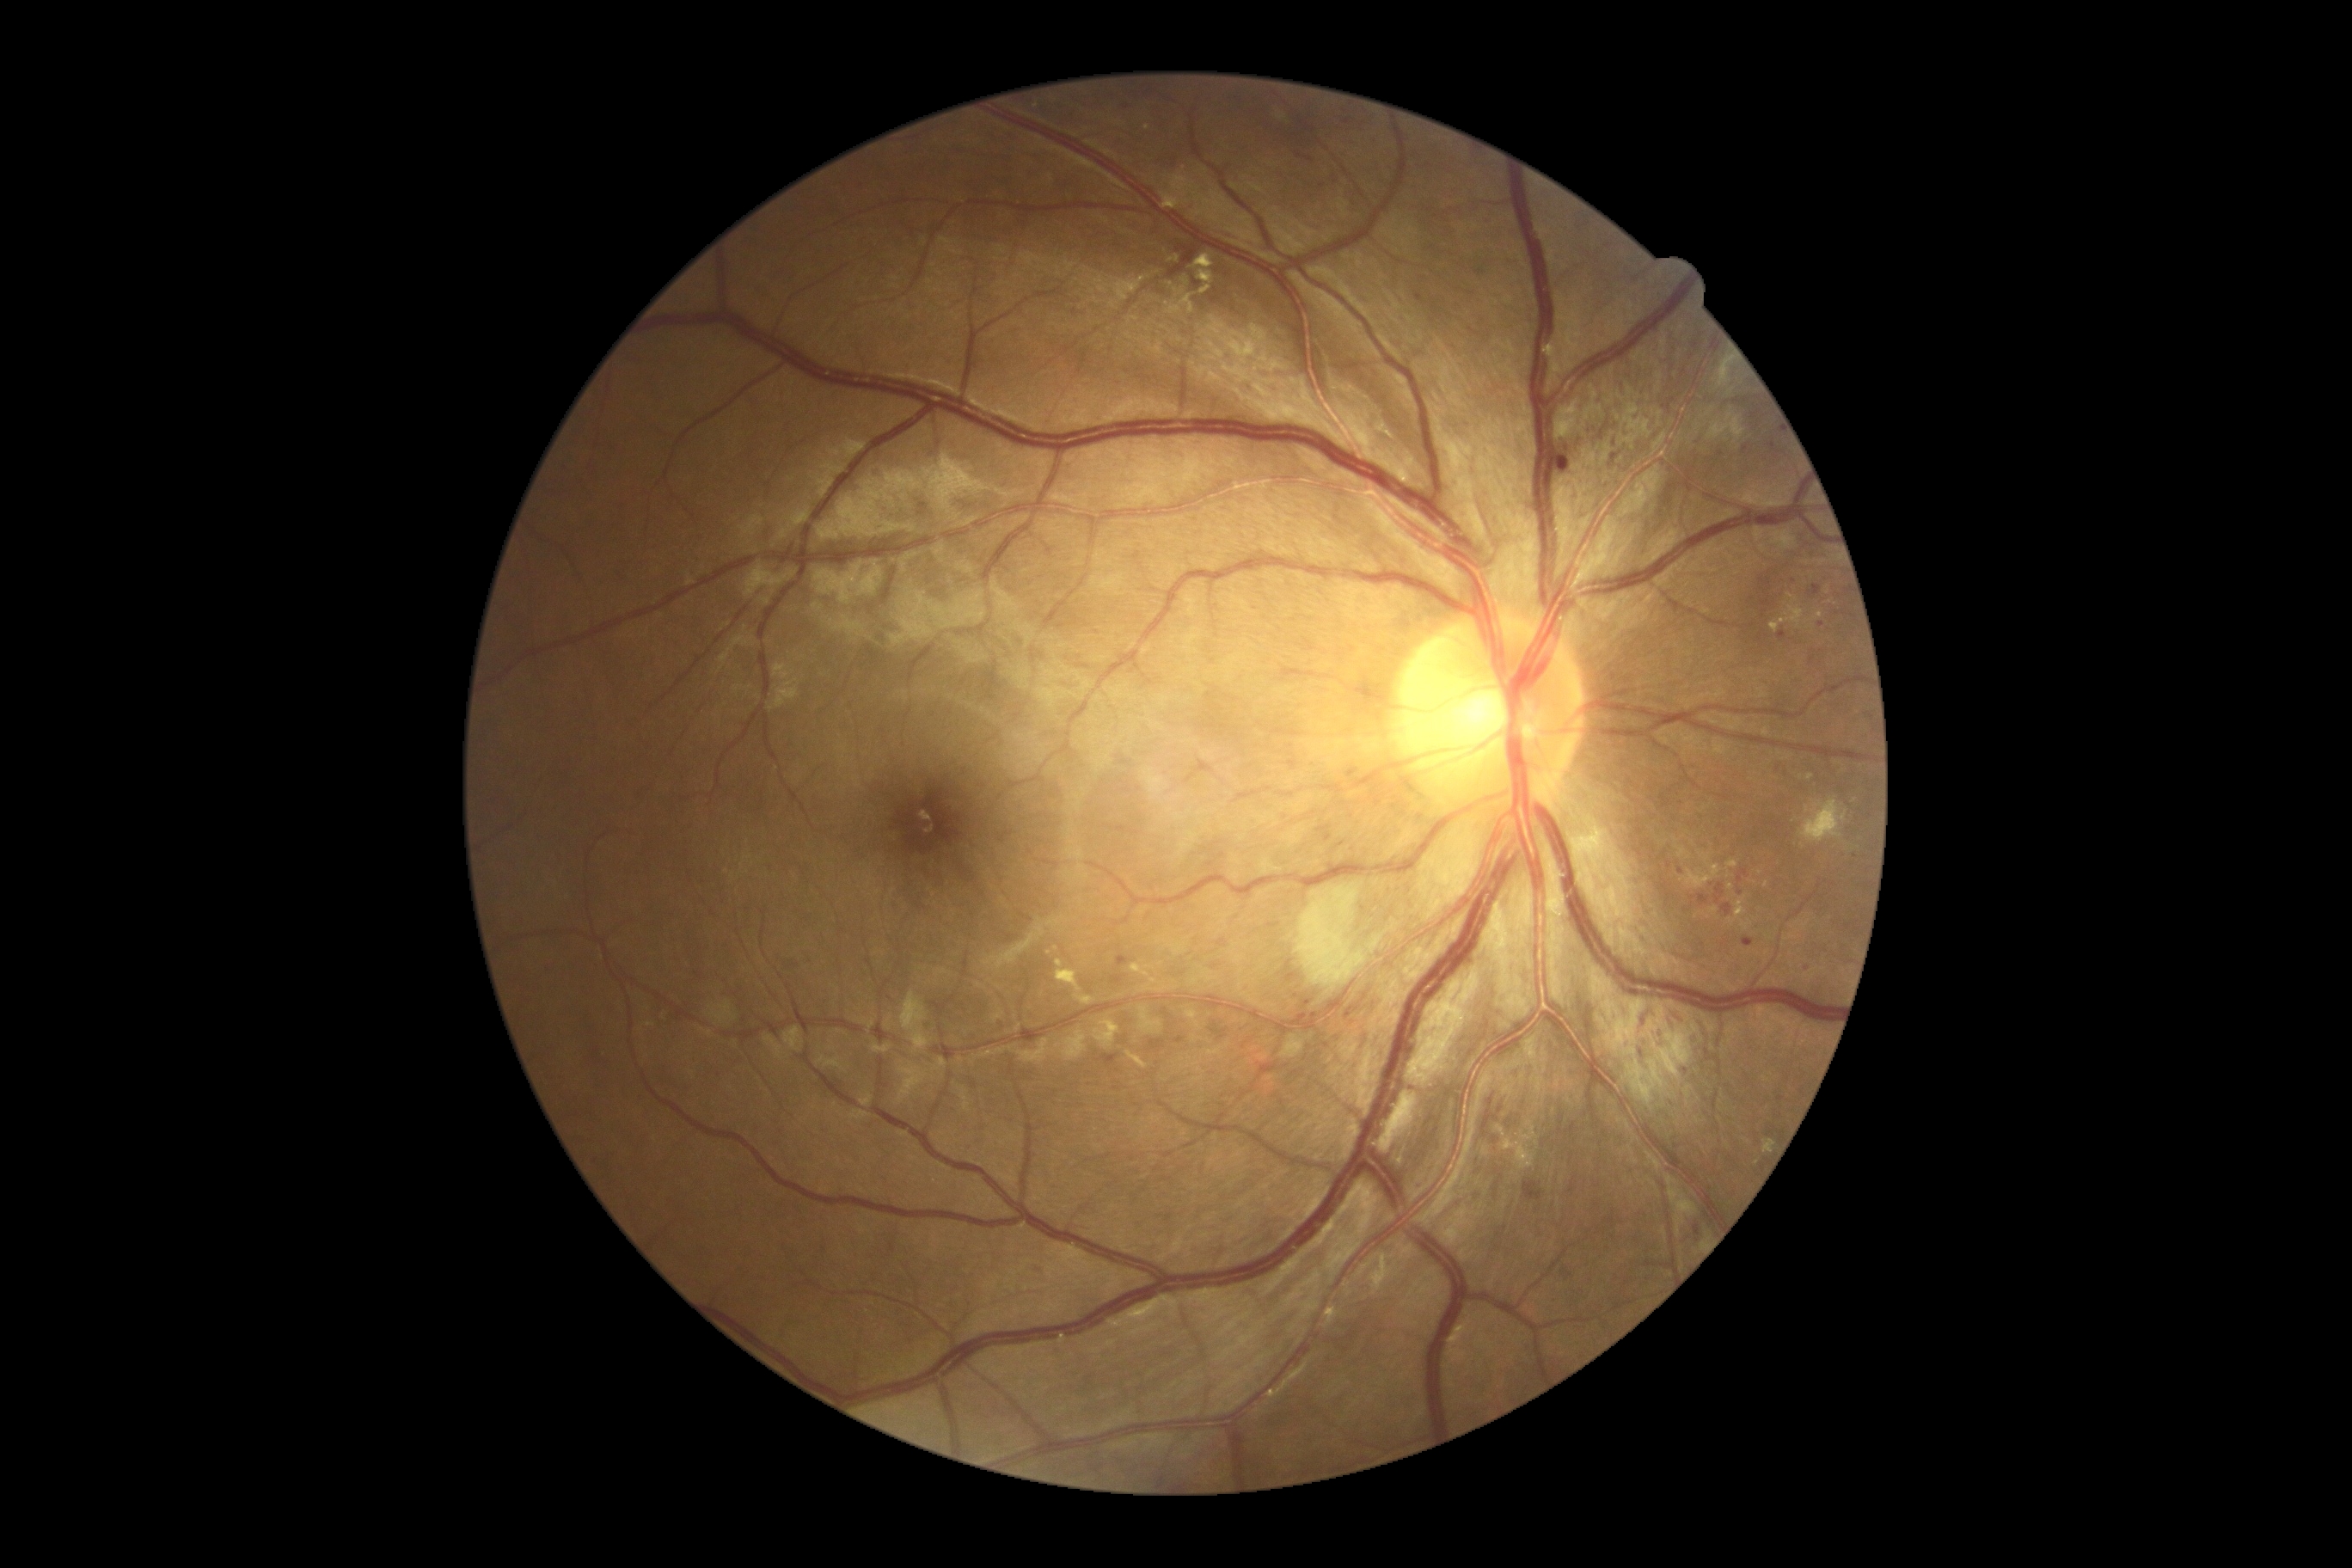

{"partial":true,"dr_grade":2,"lesions":{"ex":[[1094,1020,1120,1050],[1130,964,1149,977],[1763,728,1770,737],[1201,286,1211,295],[1700,866,1718,888],[1763,1139,1773,1155],[1502,1122,1538,1170],[1199,271,1215,285],[1156,988,1168,993],[1192,254,1215,269]],"ex_small_centers":[[1057,949],[1758,1163],[1855,801],[1730,887],[1789,757],[1799,625]],"ma":[[1810,656,1816,666],[1811,585,1822,596],[1375,799,1381,807],[1559,451,1572,472],[1347,769,1357,778],[1608,451,1619,467],[1112,976,1125,984],[1777,764,1782,773],[1844,924,1854,933],[1743,940,1755,946],[1318,826,1332,833]],"ma_small_centers":[[1868,717],[1681,871],[1684,372]],"se":[[1718,357,1734,386],[1694,398,1748,444],[1799,800,1847,845]],"he":[[1522,1180,1543,1203],[1722,903,1734,917],[1737,871,1748,883],[1641,1012,1653,1026],[1507,1120,1510,1129],[1689,1220,1705,1244],[1304,157,1314,162],[1483,1096,1498,1137],[1667,1008,1693,1031],[1698,895,1710,905],[1639,1046,1645,1058],[1717,885,1725,905],[1684,1065,1693,1084]],"he_small_centers":[[1692,898],[1741,893],[1494,1140],[1298,154]]}}